RetCam wide-field infant fundus image; 640x480; captured with the Clarity RetCam 3 (130° field of view):
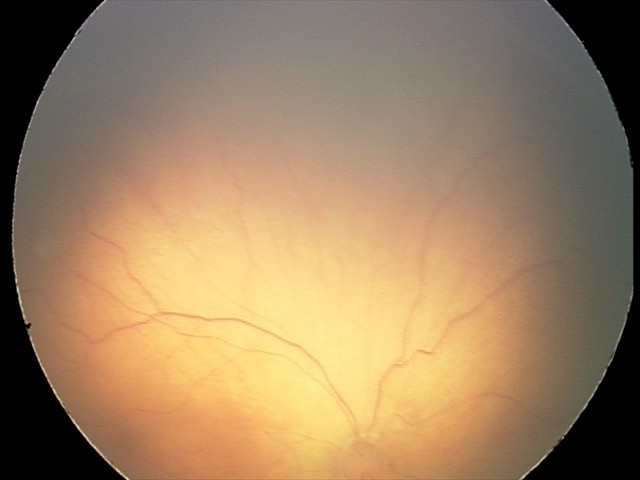

Diagnosis from this screening exam: retinopathy of prematurity (ROP) stage 2.
Without plus disease.